848x848 · NIDEK AFC-230 fundus camera.
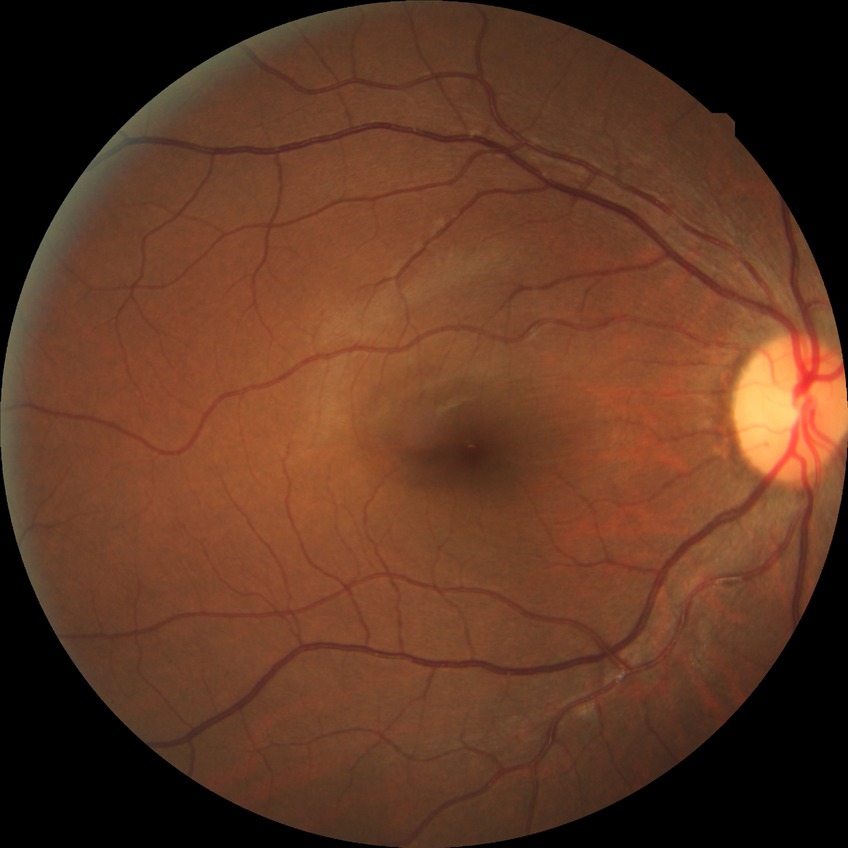

Diabetic retinopathy (DR) is no diabetic retinopathy (NDR).